Pediatric wide-field fundus photograph — 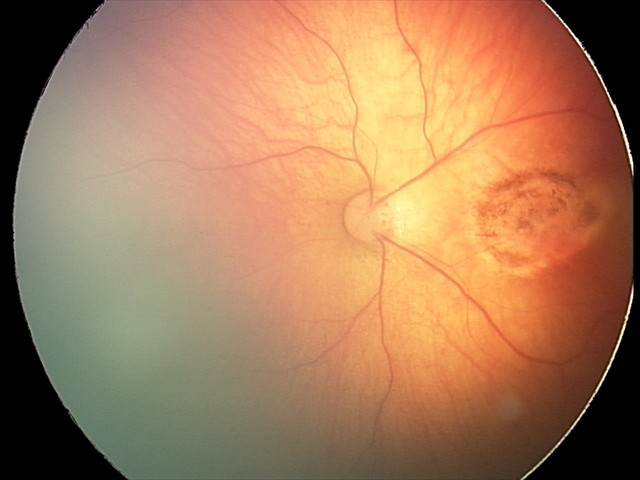

Screening series with toxoplasmosis chorioretinitis.